Acquired on the Phoenix ICON · 1240x1240 · infant wide-field fundus photograph: 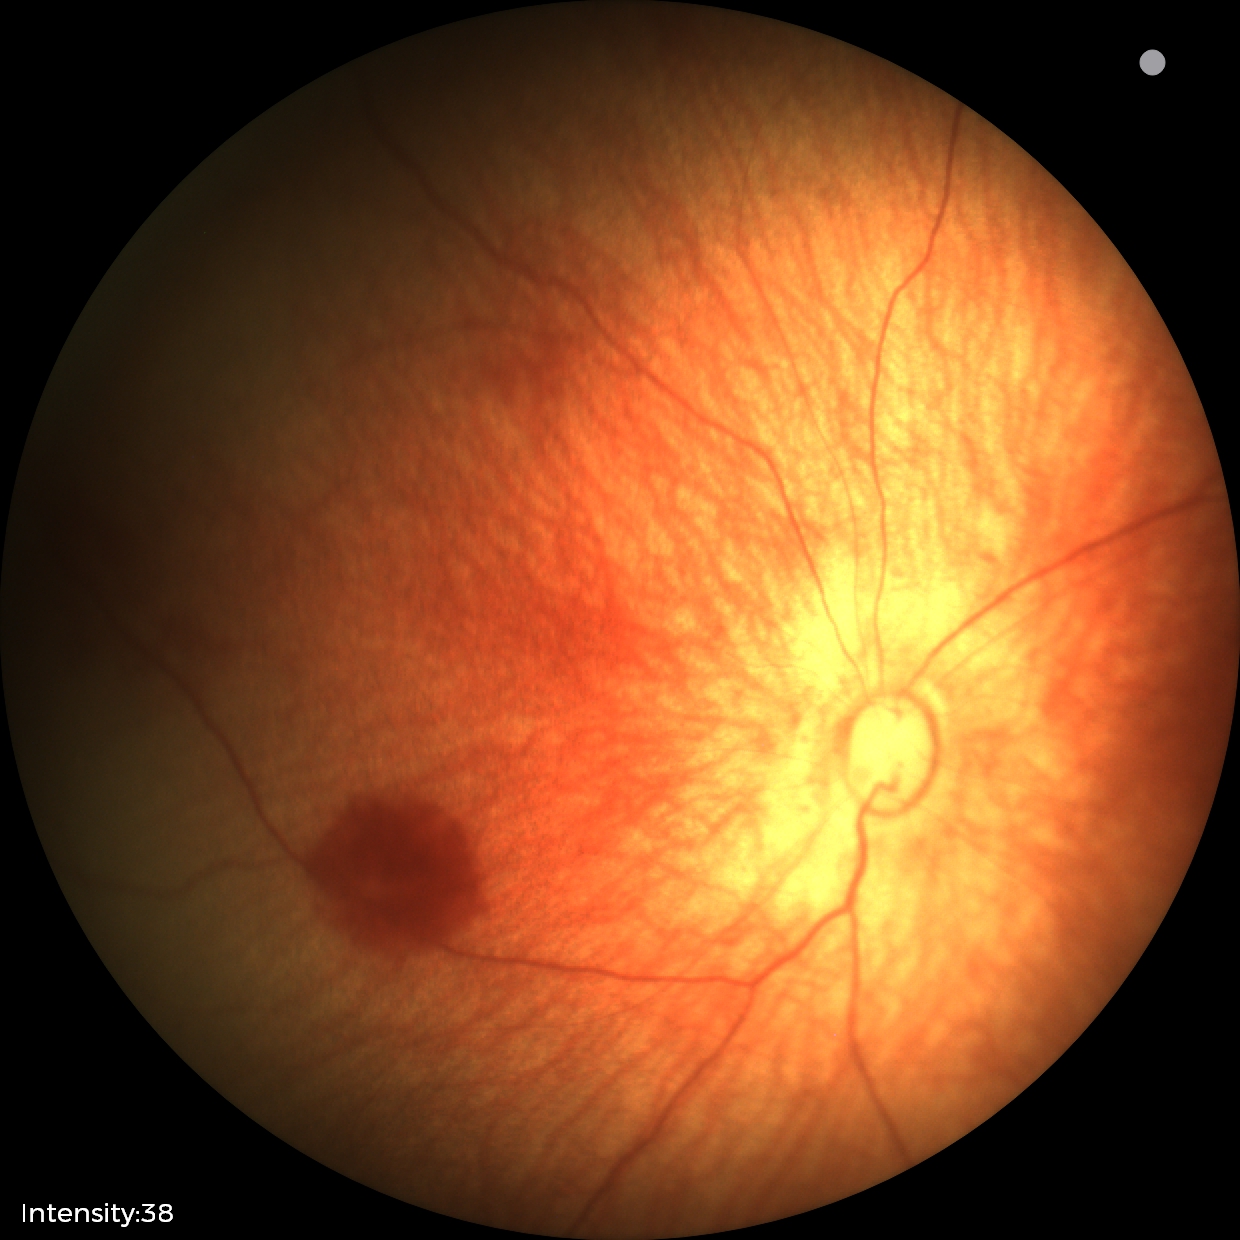 No retinal pathology identified on screening.